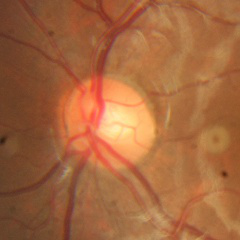
Fundus appearance consistent with no signs of glaucoma.